Clarity RetCam 3, 130° FOV. Image size 640x480. Pediatric wide-field fundus photograph
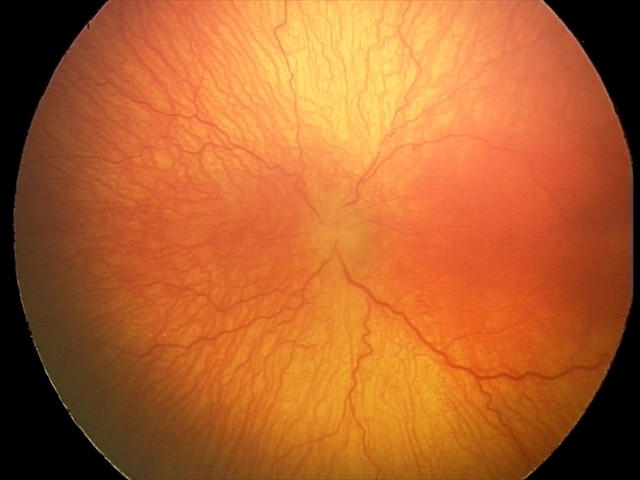 Assessment: aggressive retinopathy of prematurity (A-ROP) — rapidly progressive severe ROP with prominent plus disease, often without classic stage progression.